FOV: 45 degrees; 2048 by 1536 pixels; fundus photo:
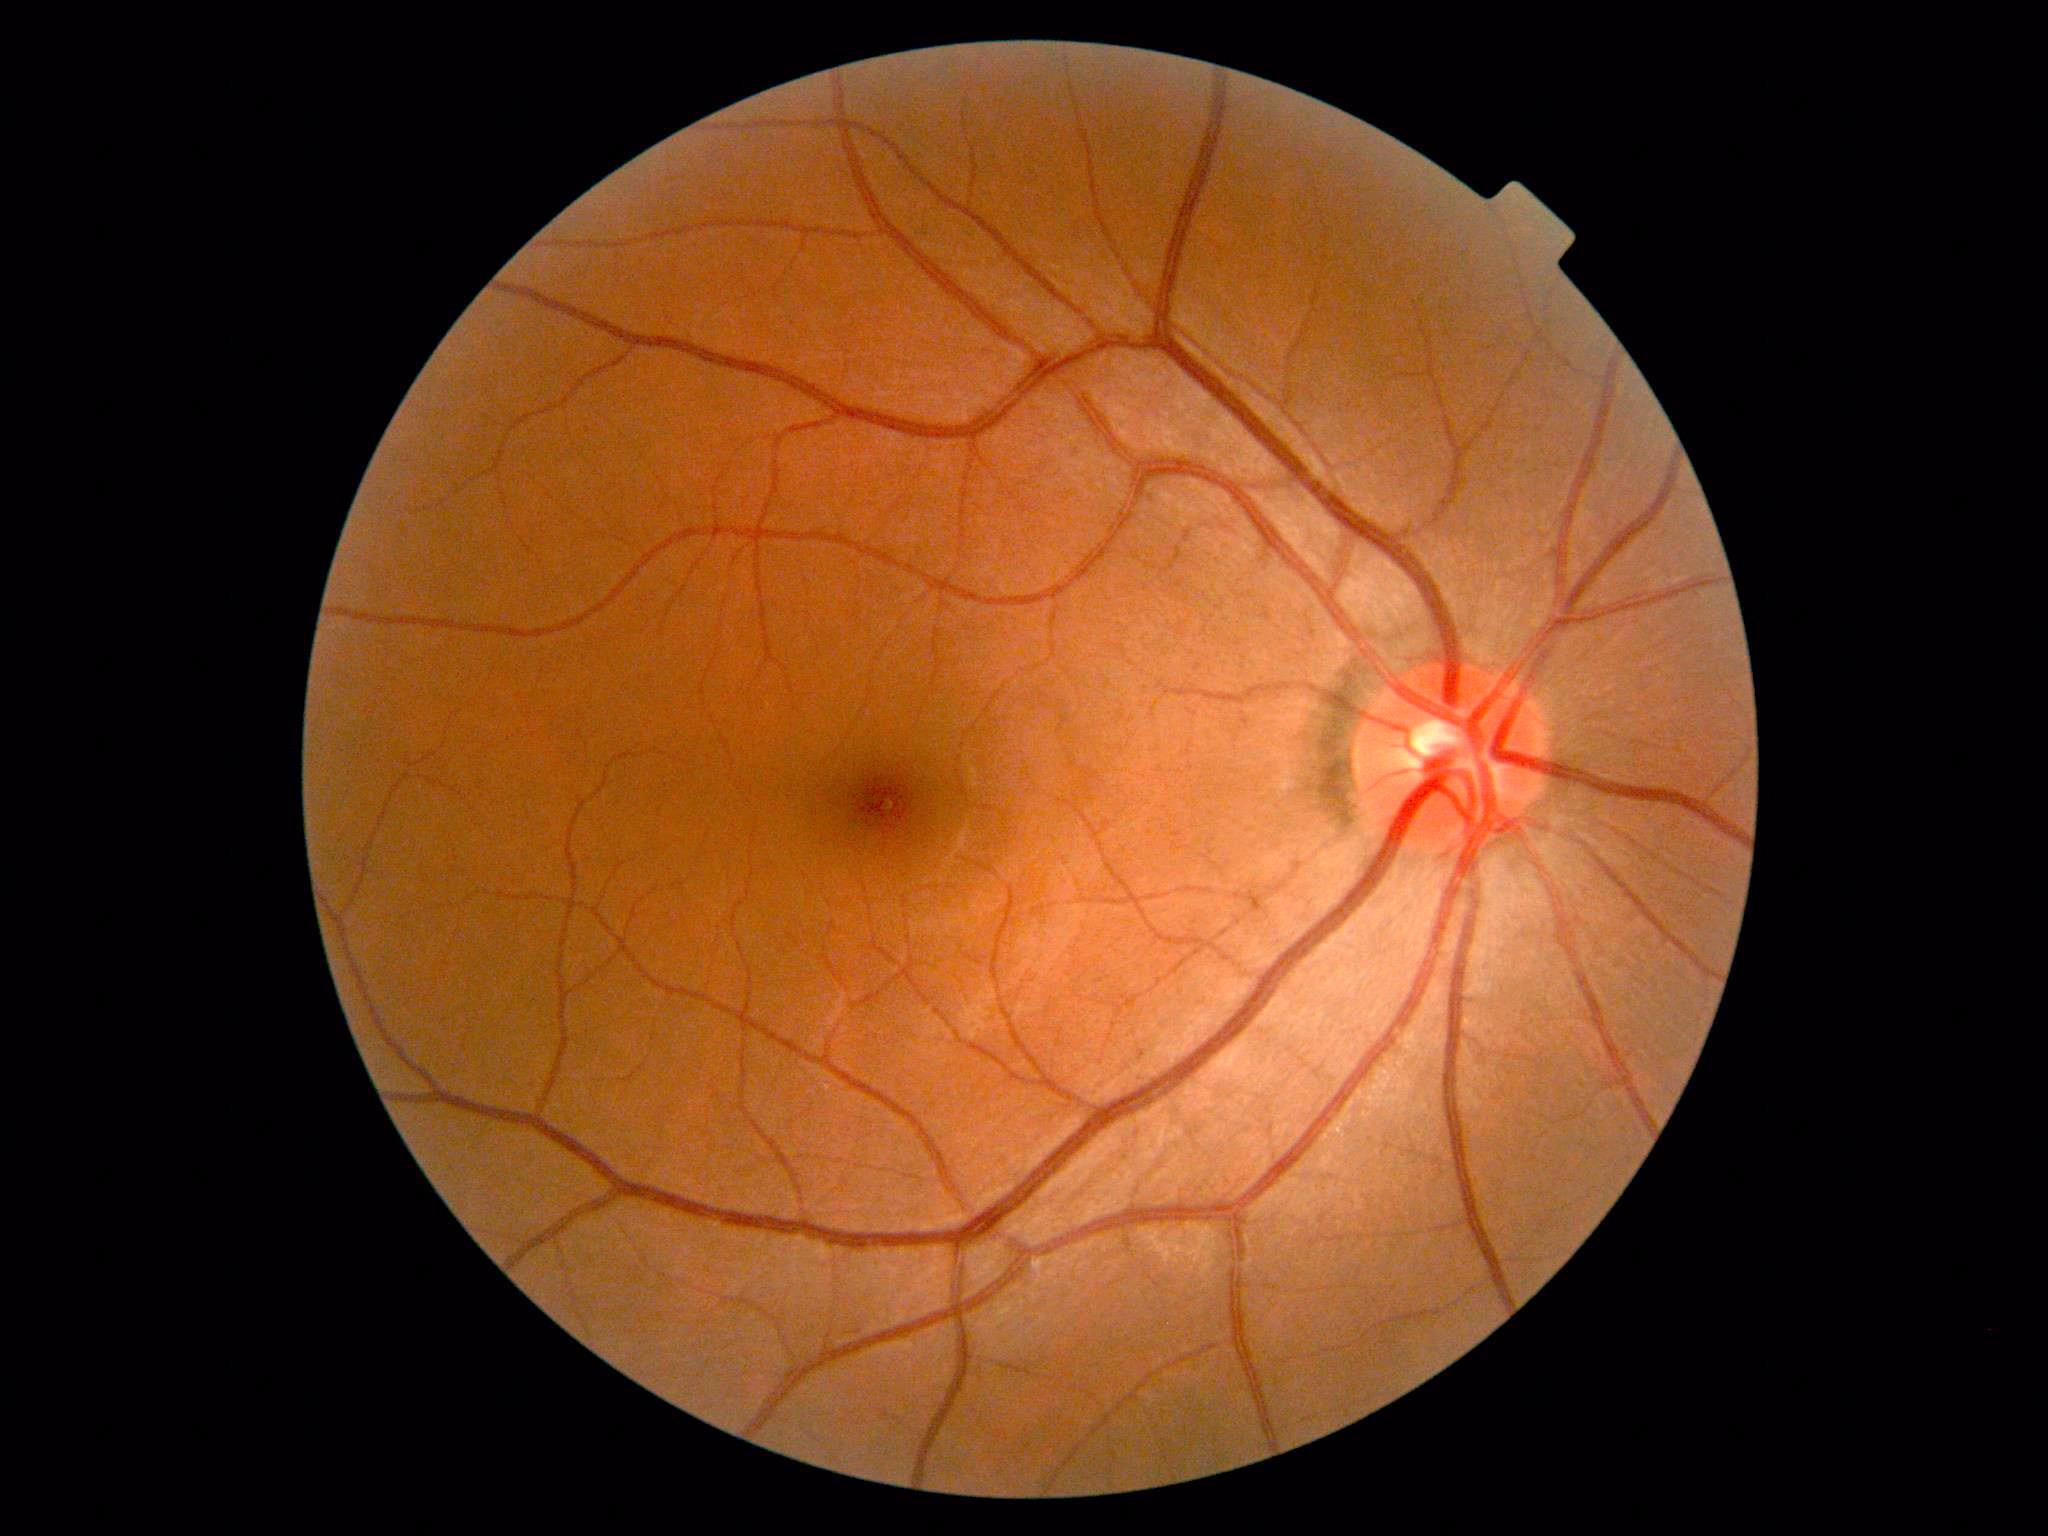

No diabetic retinal disease findings.
DR severity is grade 0 (no apparent retinopathy) — no visible signs of diabetic retinopathy.